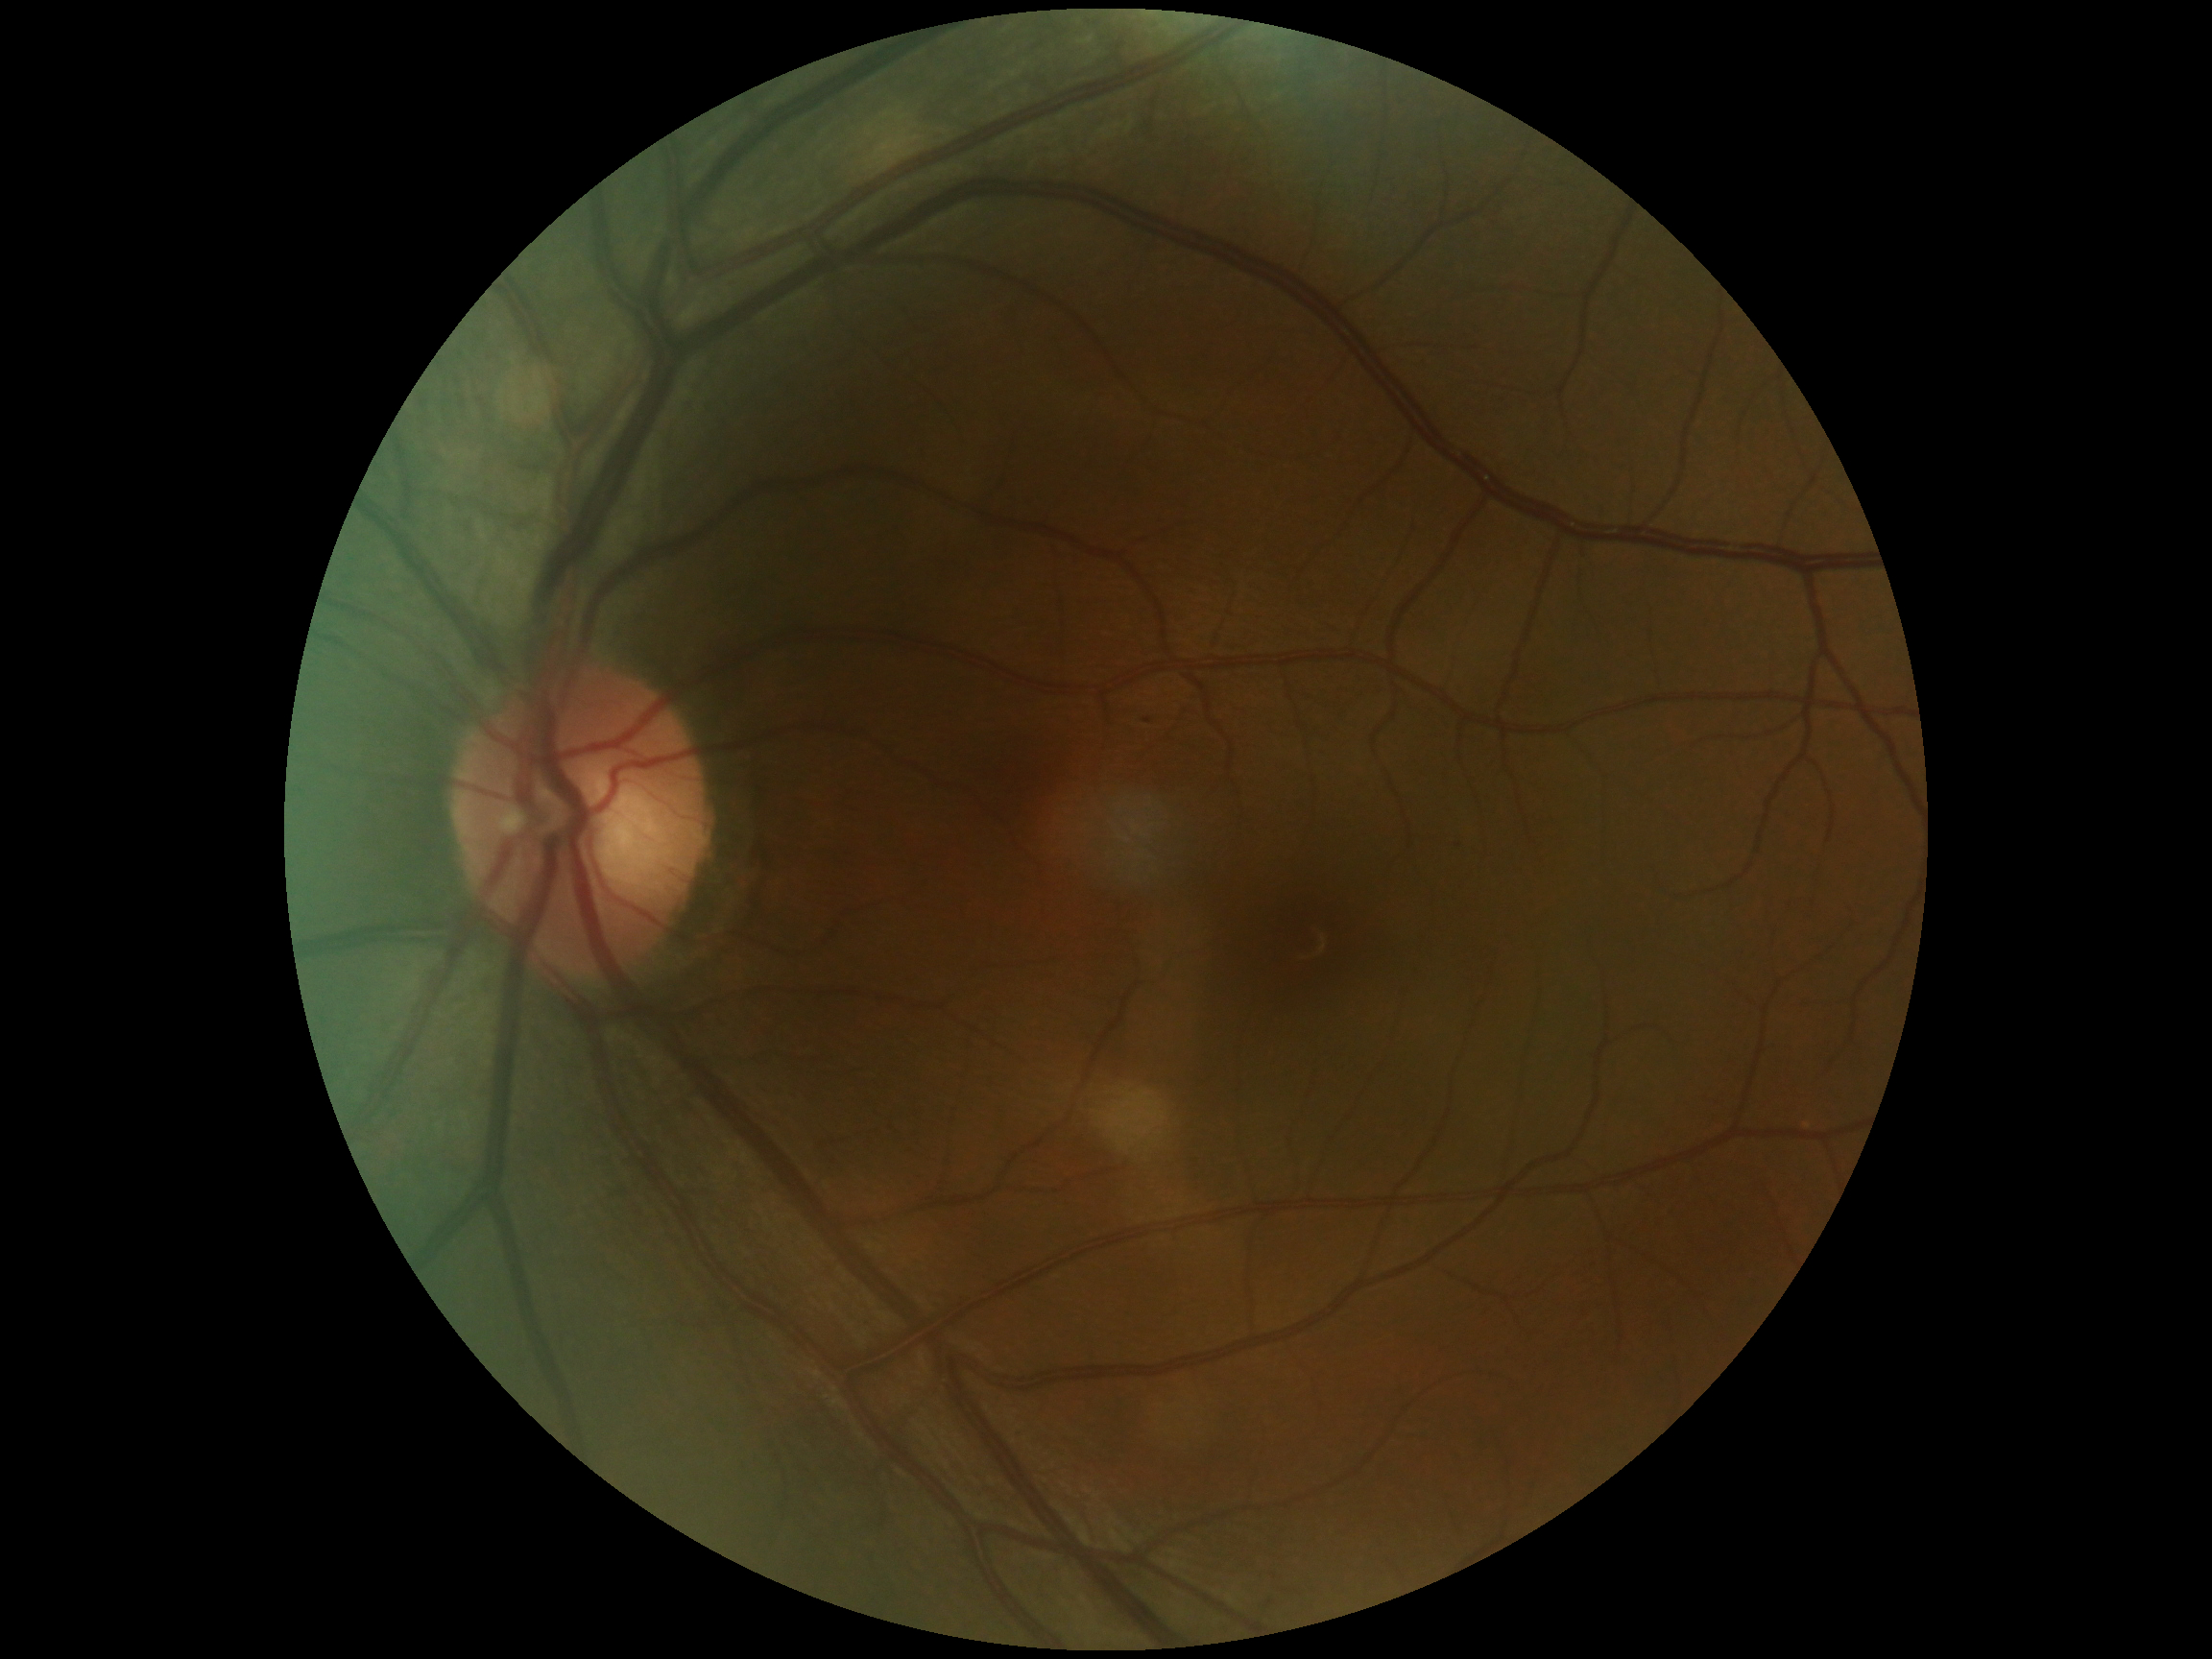
DR: 1/4.